Posterior pole view:
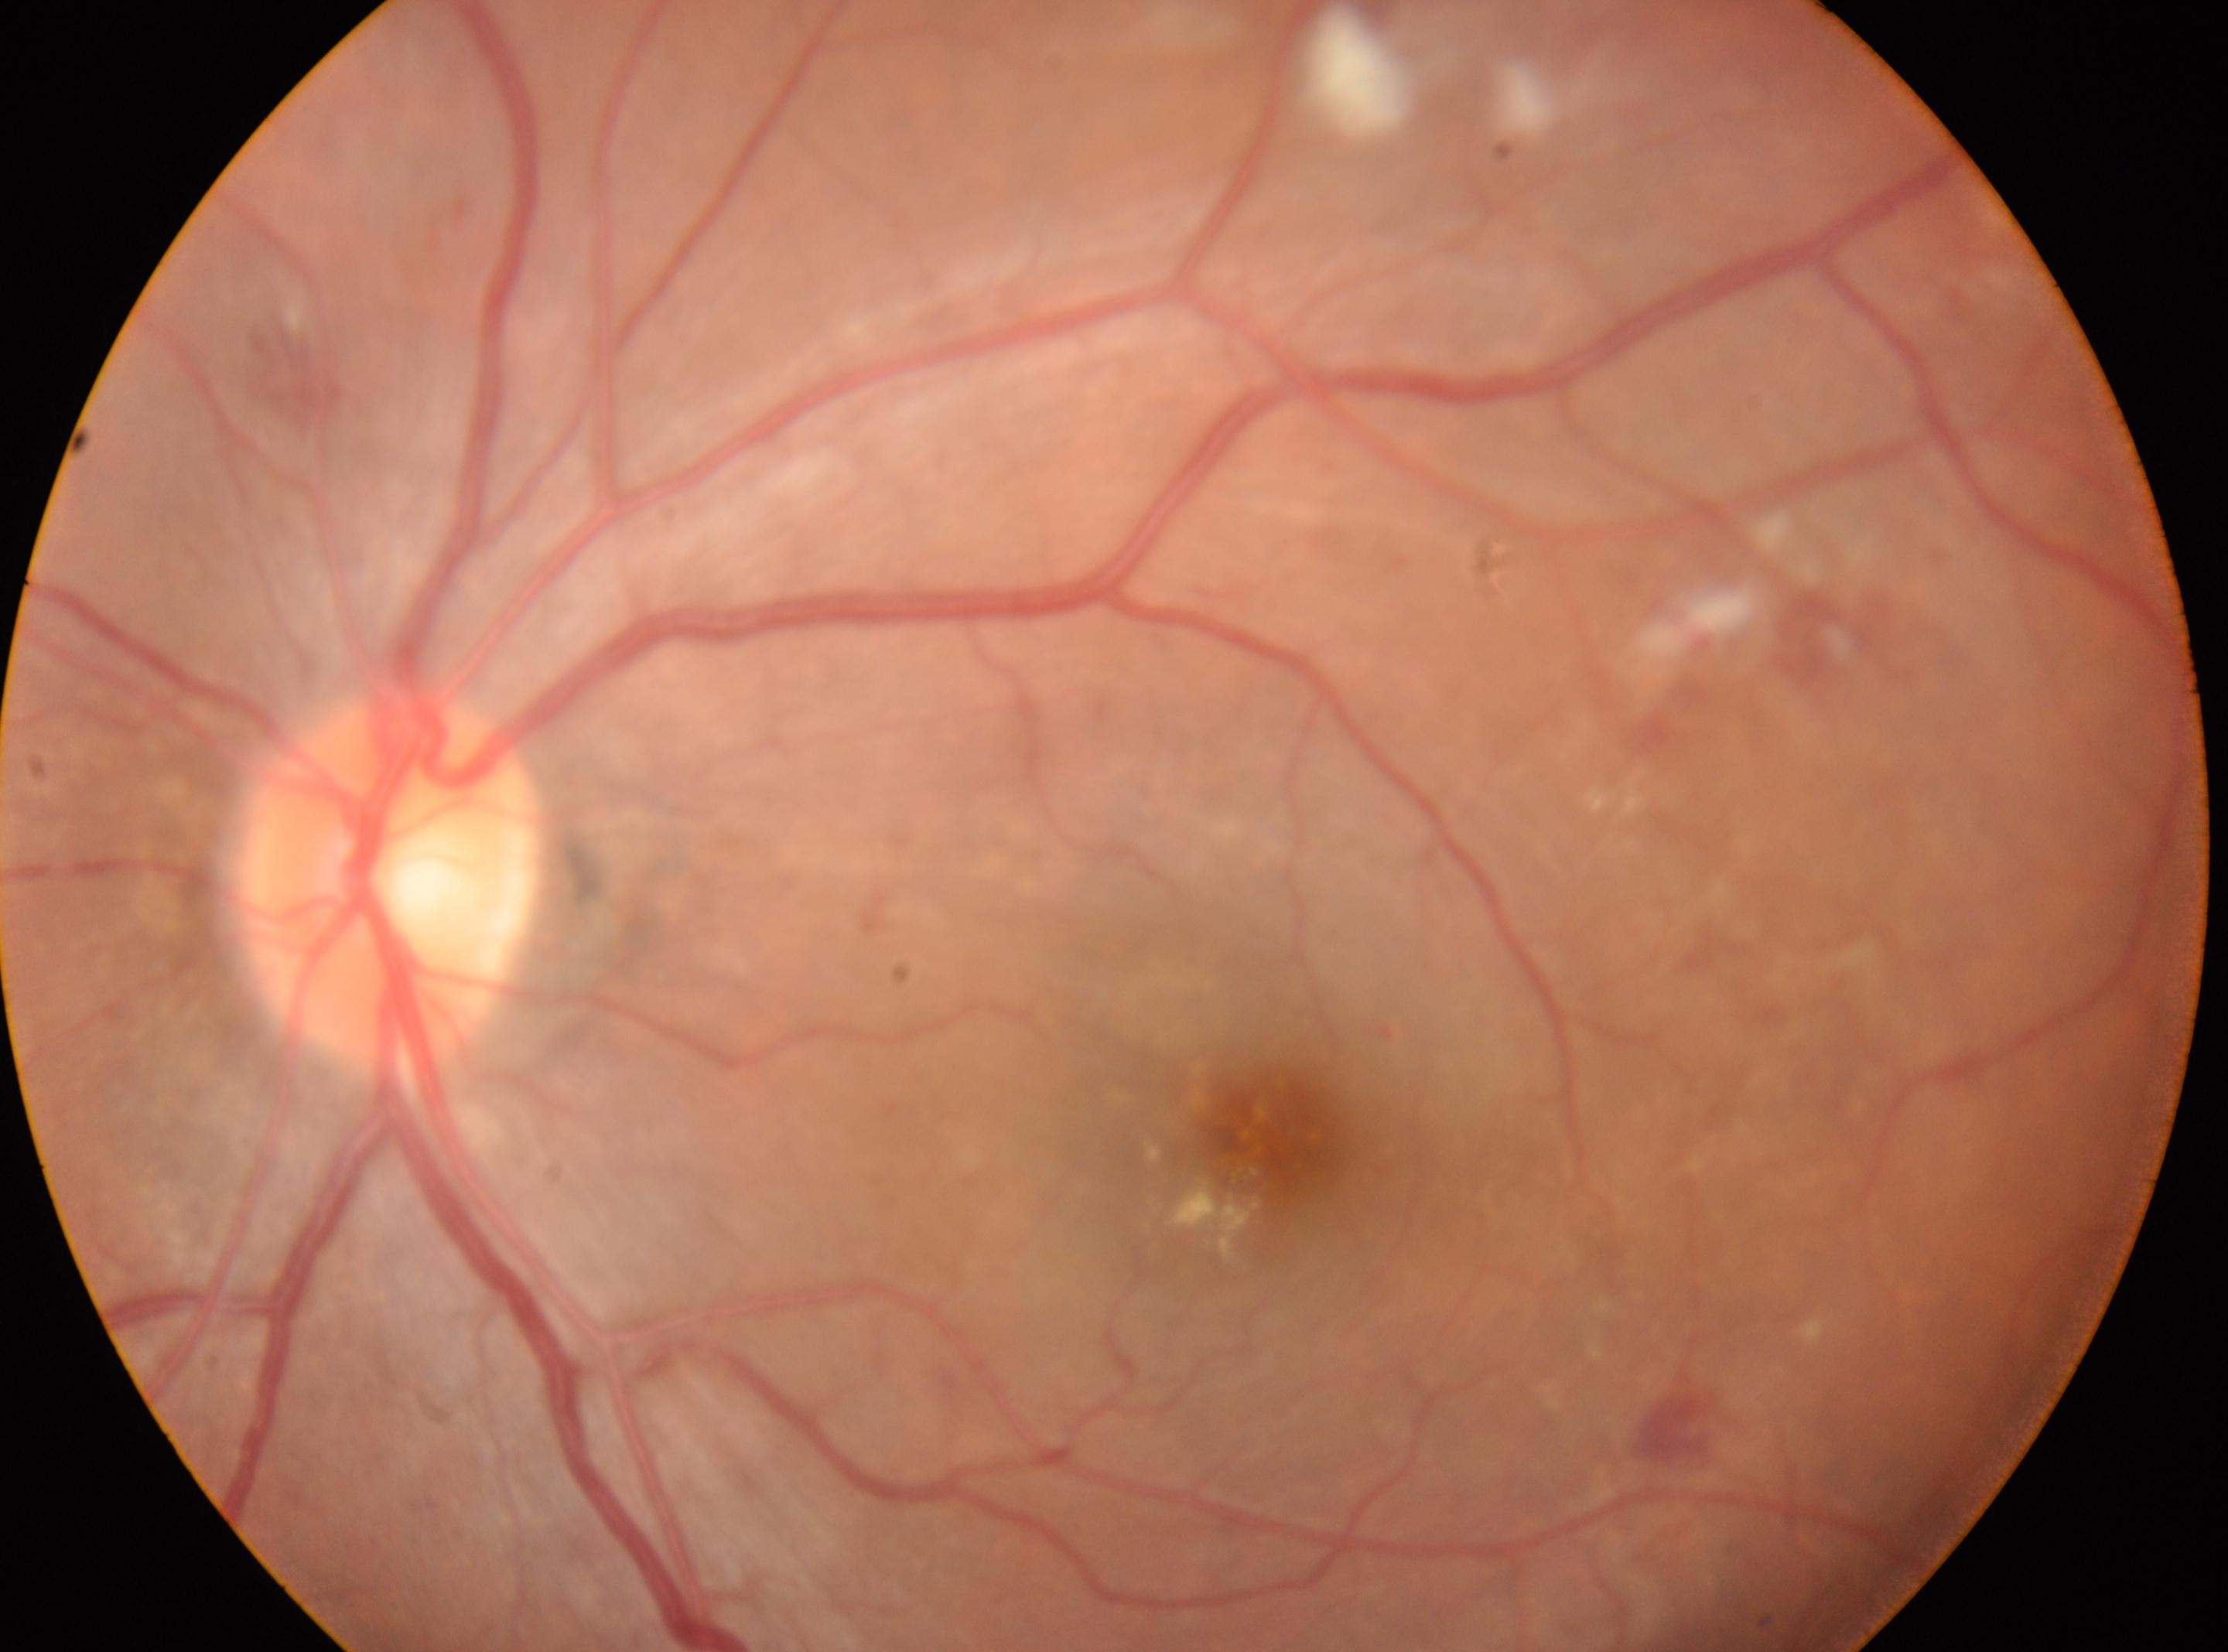 - eye · OS
- macular center · (1276, 1137)
- optic disc · (390, 875)
- DR stage · 2